Color fundus photograph.
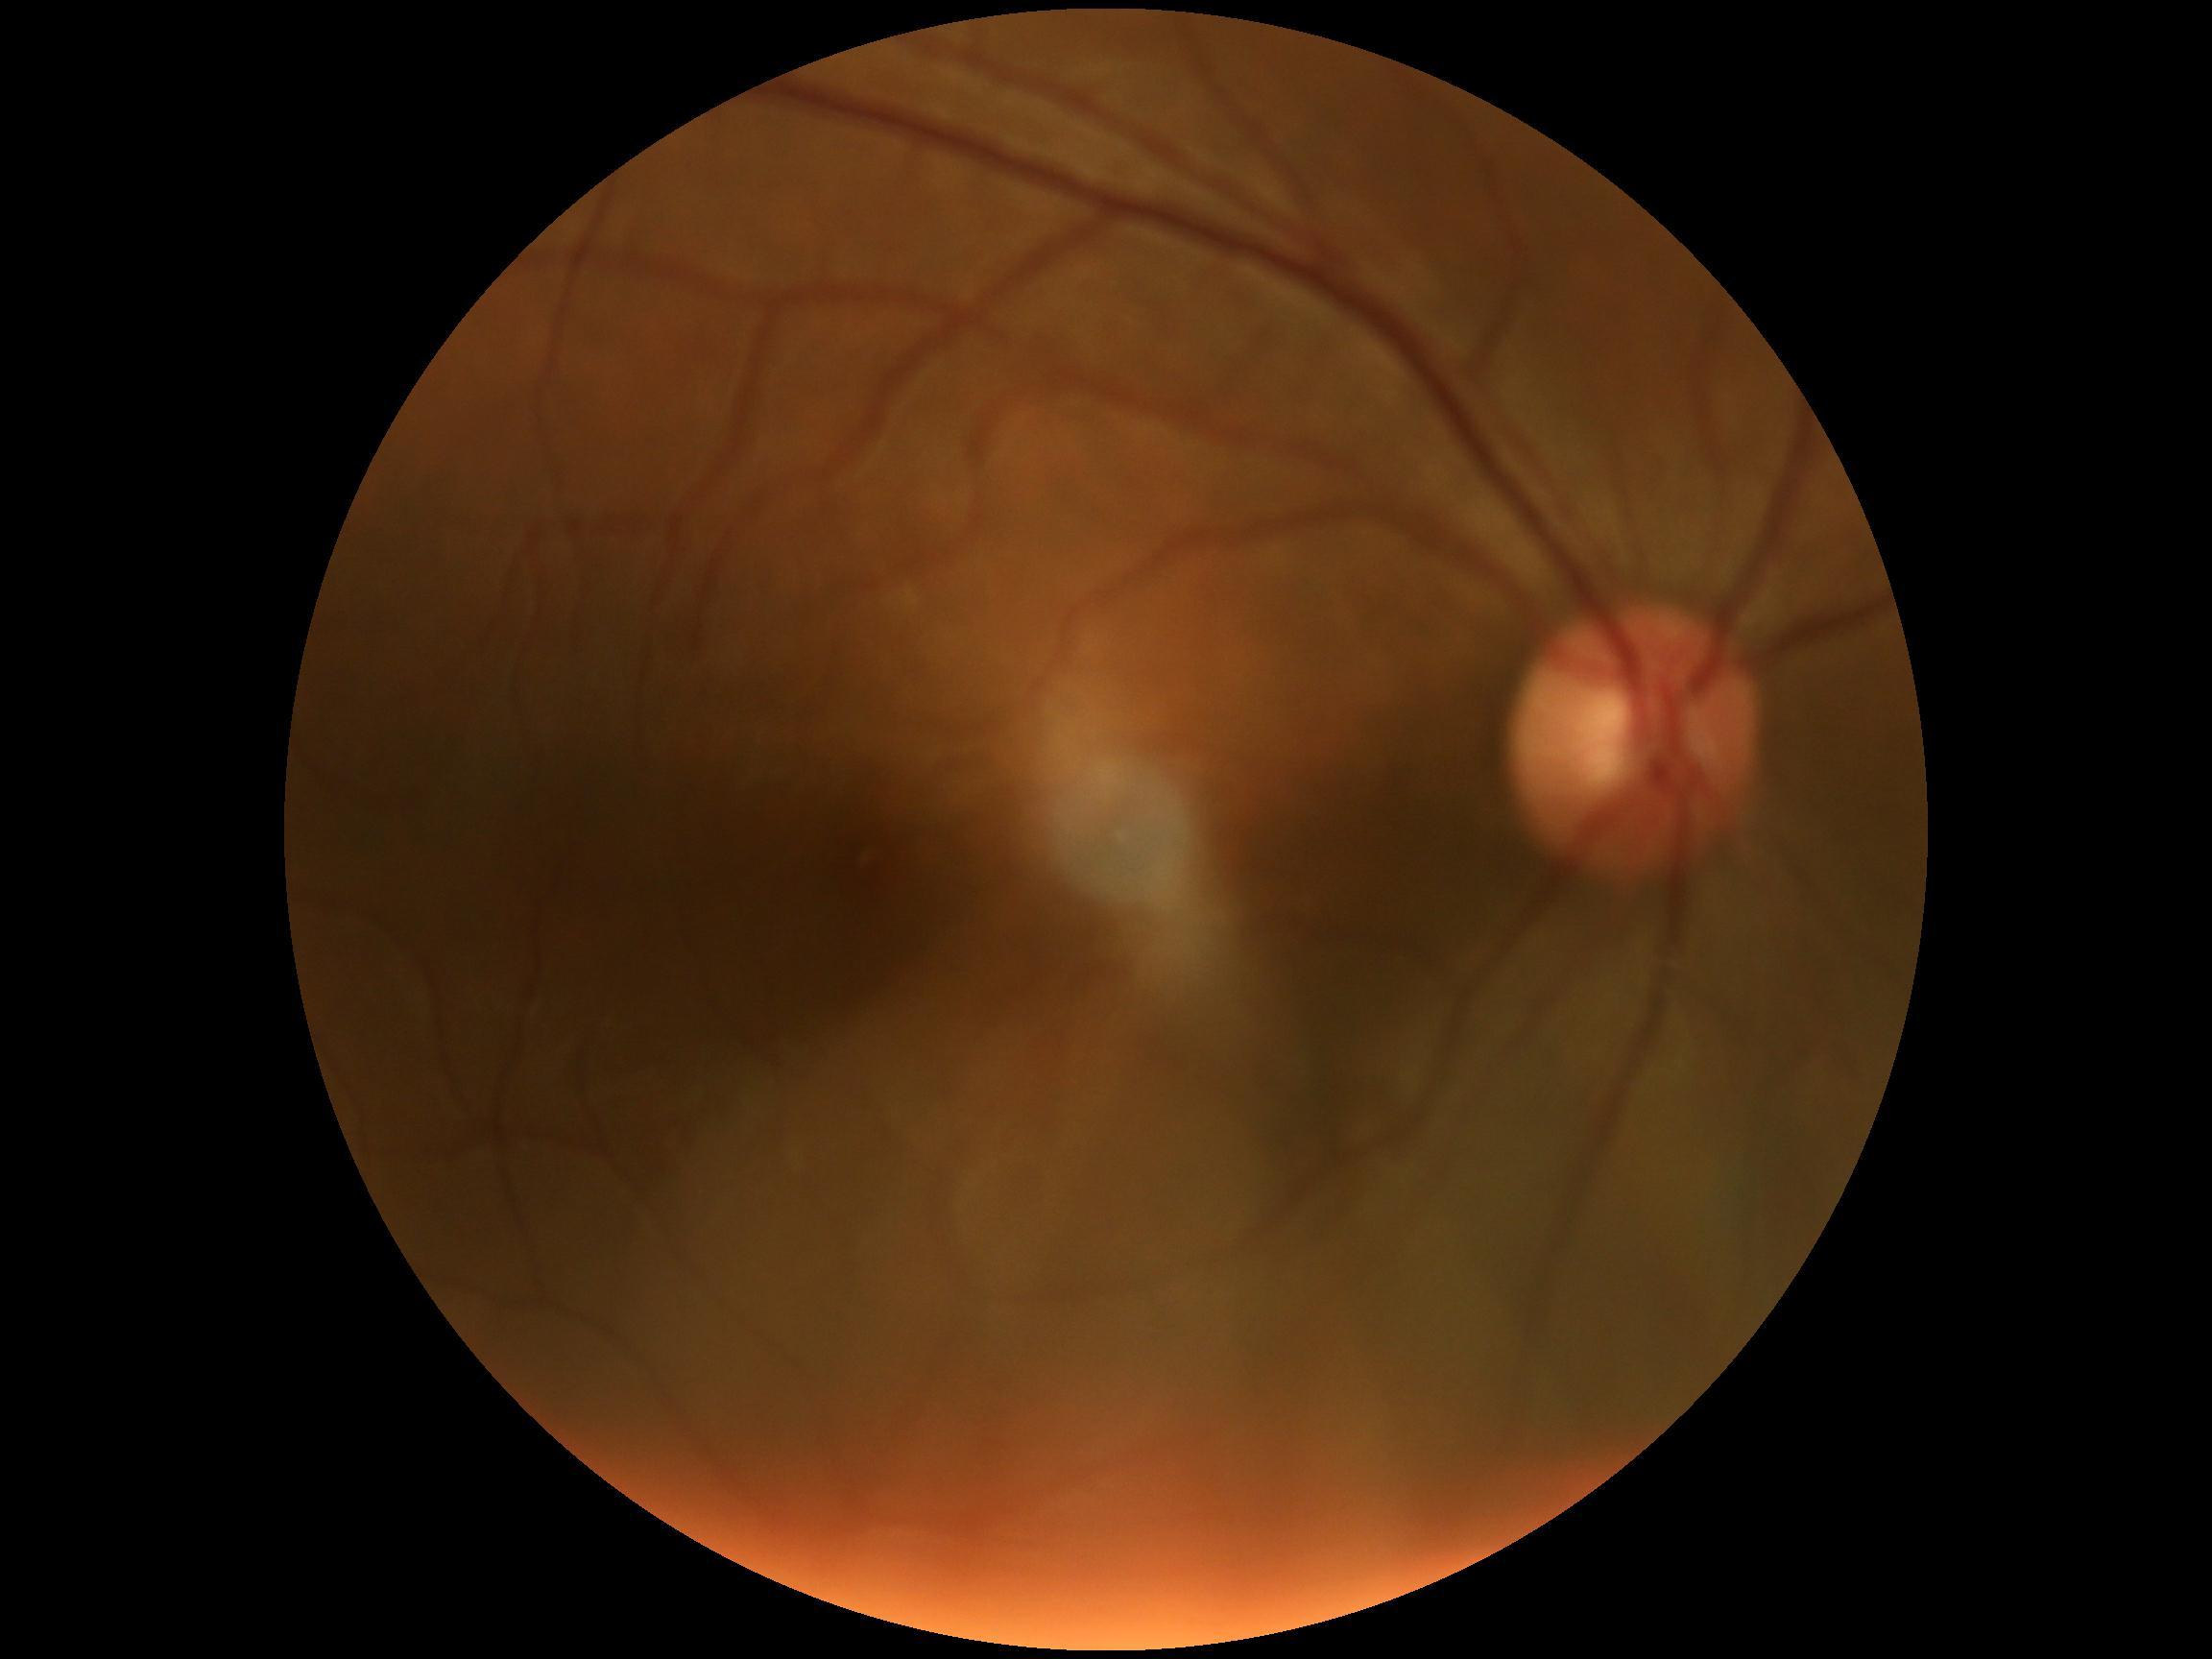
  dr_grade: no apparent diabetic retinopathy (grade 0)